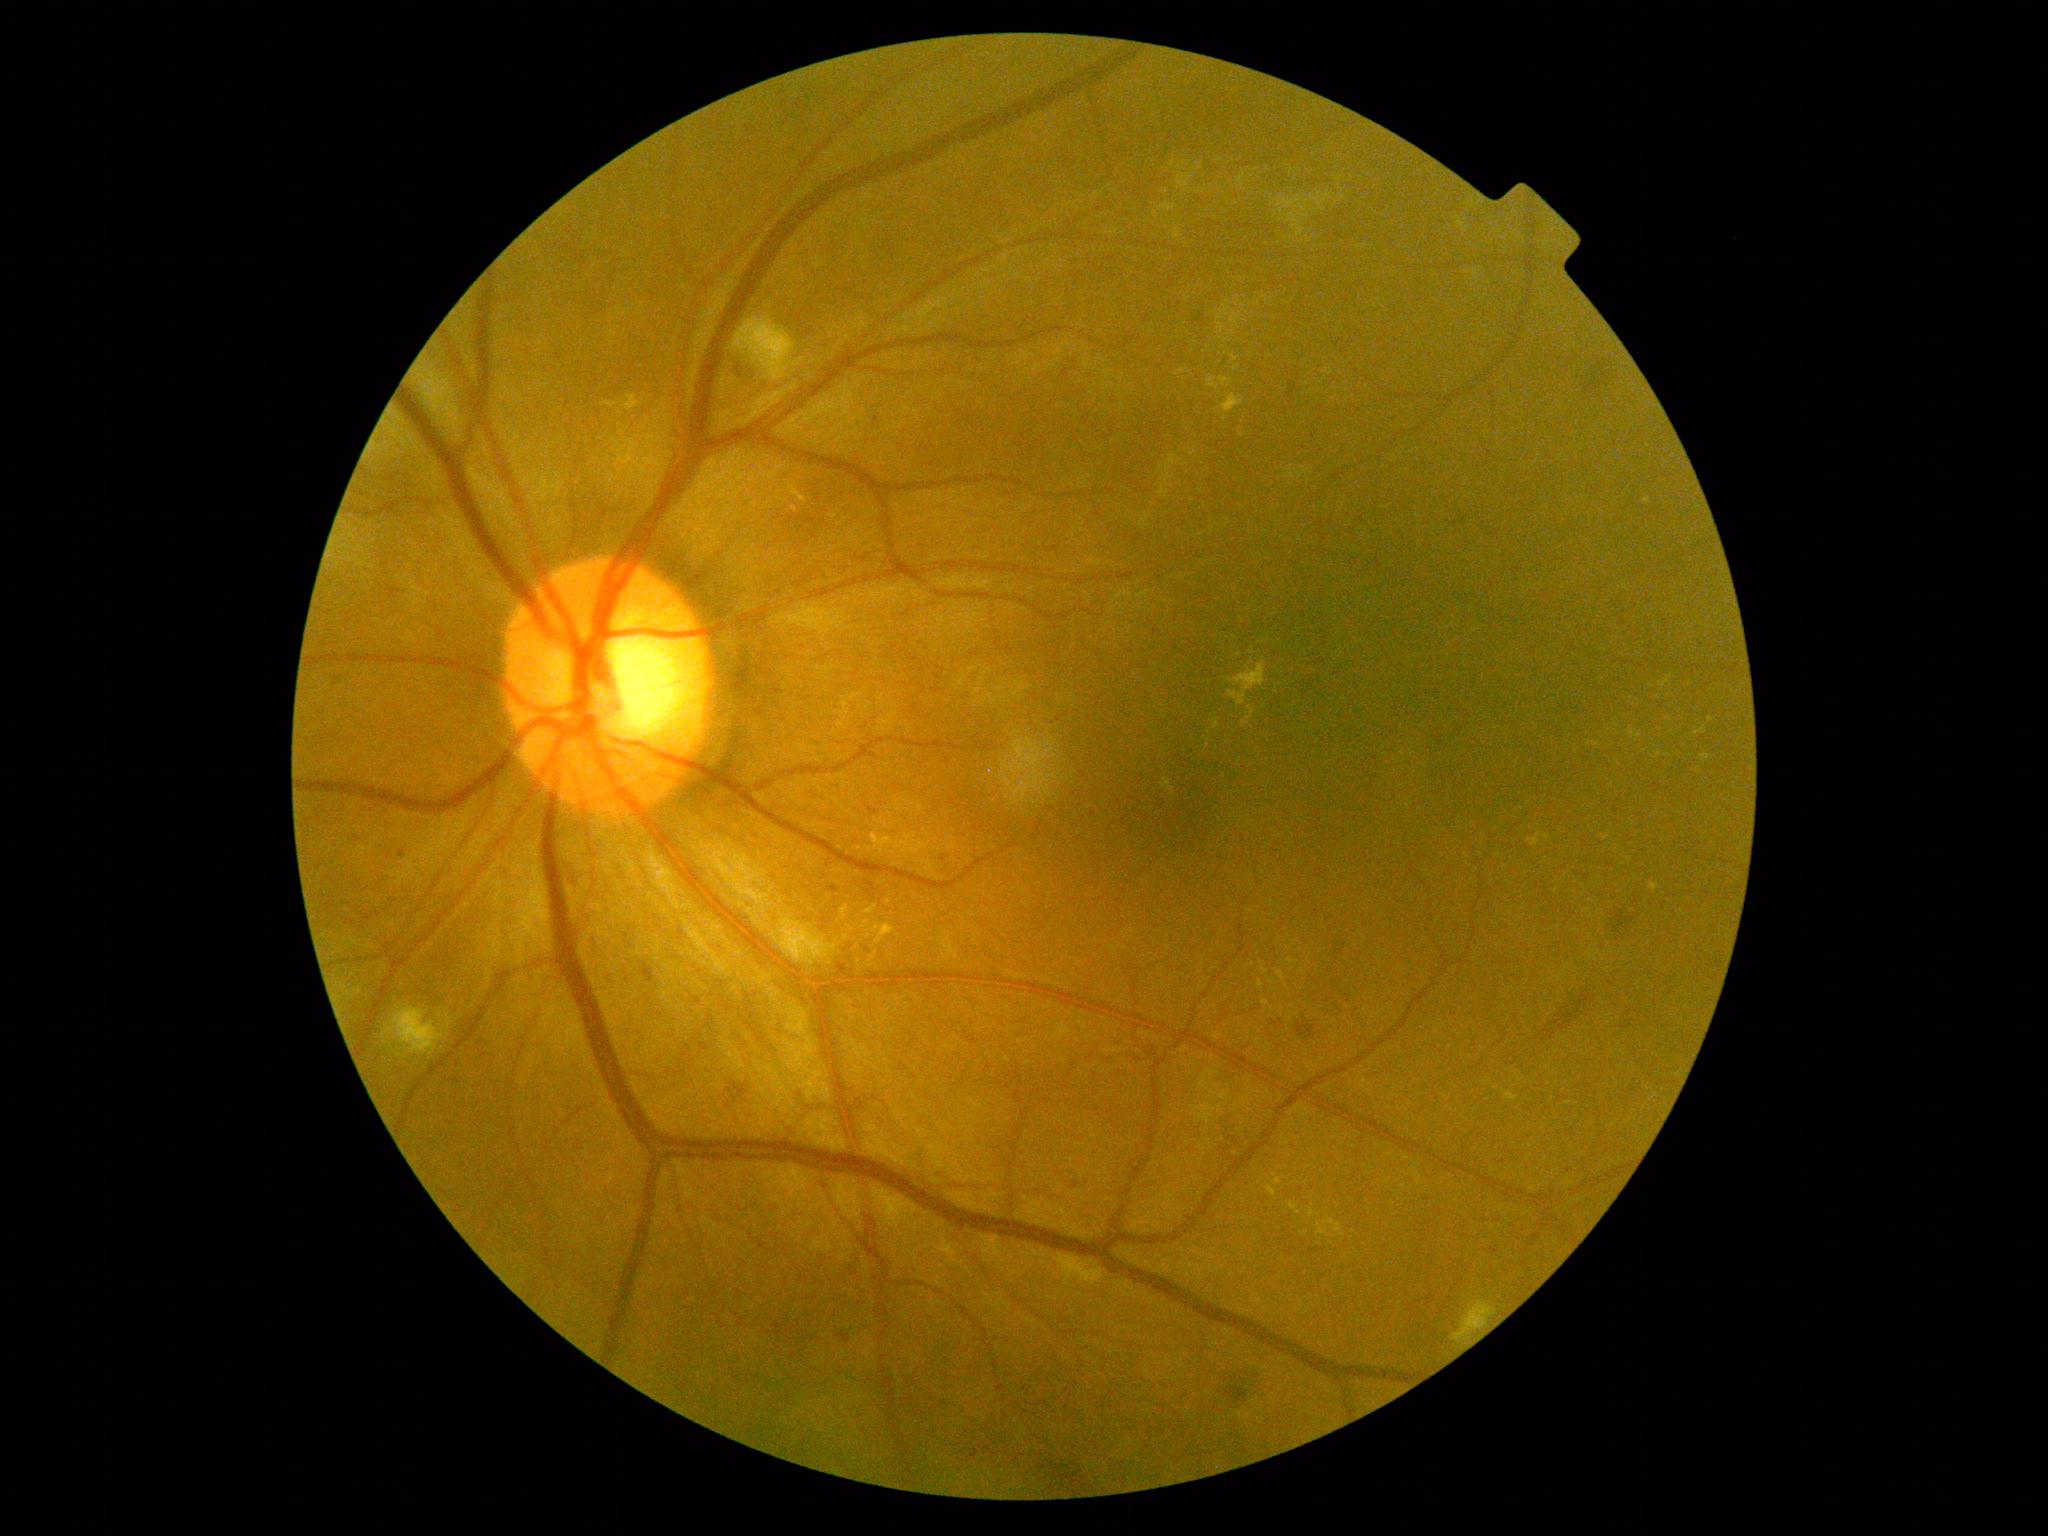

DR is grade 2 (moderate NPDR) — more than just microaneurysms but less than severe NPDR.